Modified Davis classification
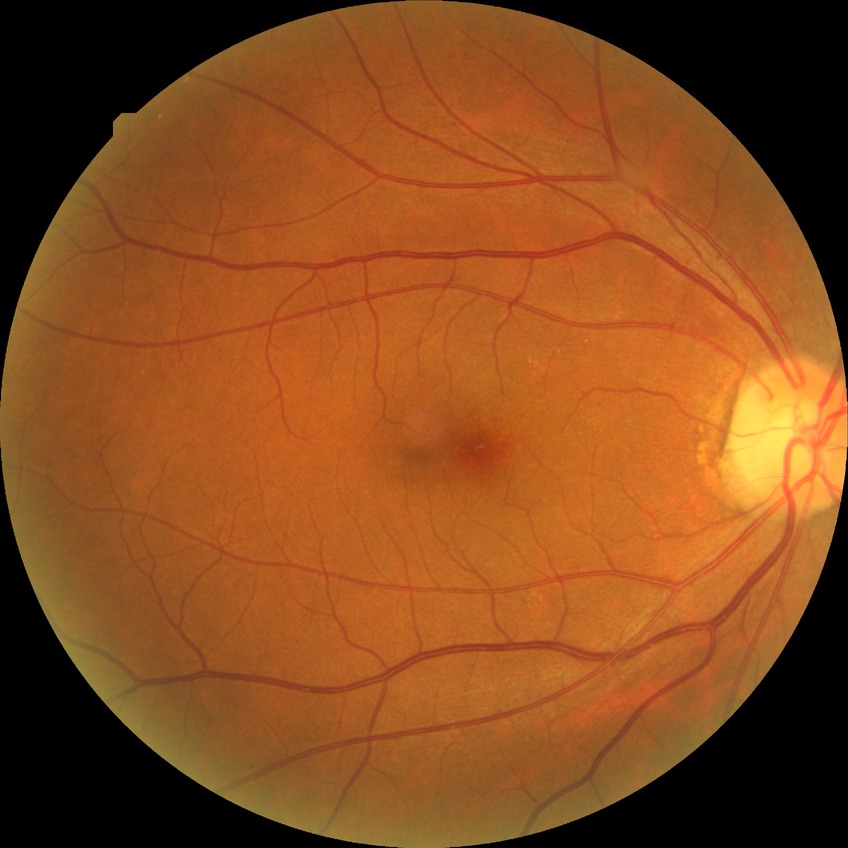

DR: SDR.